Nonmydriatic, 45° field of view, NIDEK AFC-230 fundus camera, retinal fundus photograph — 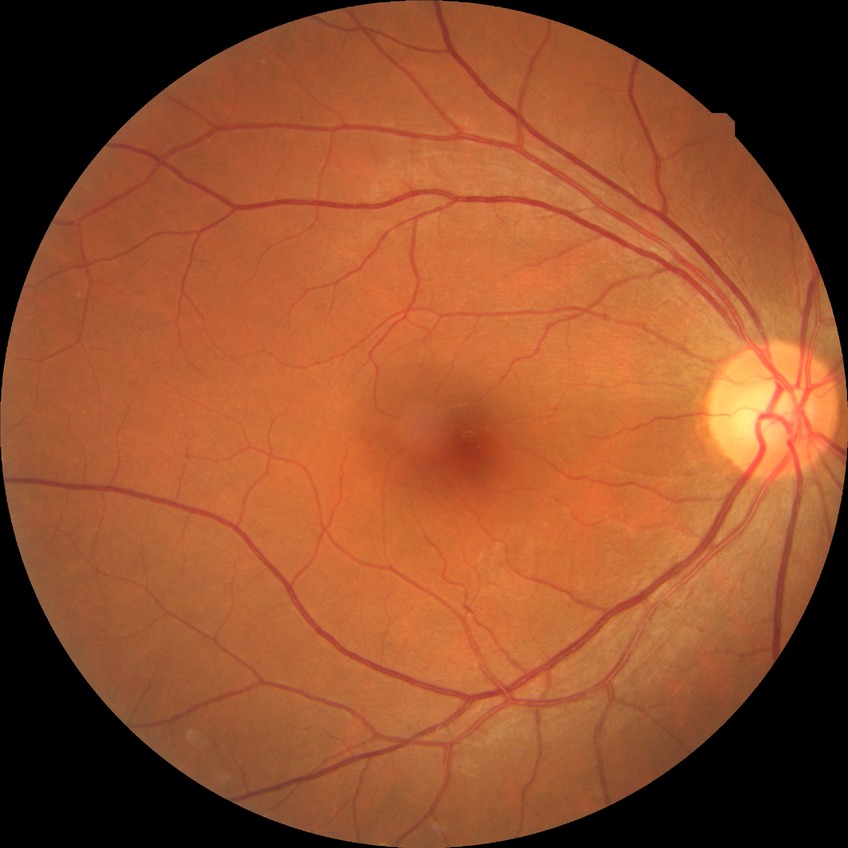

Diabetic retinopathy (DR) is no diabetic retinopathy (NDR).